Ultra-widefield (UWF) fundus image: 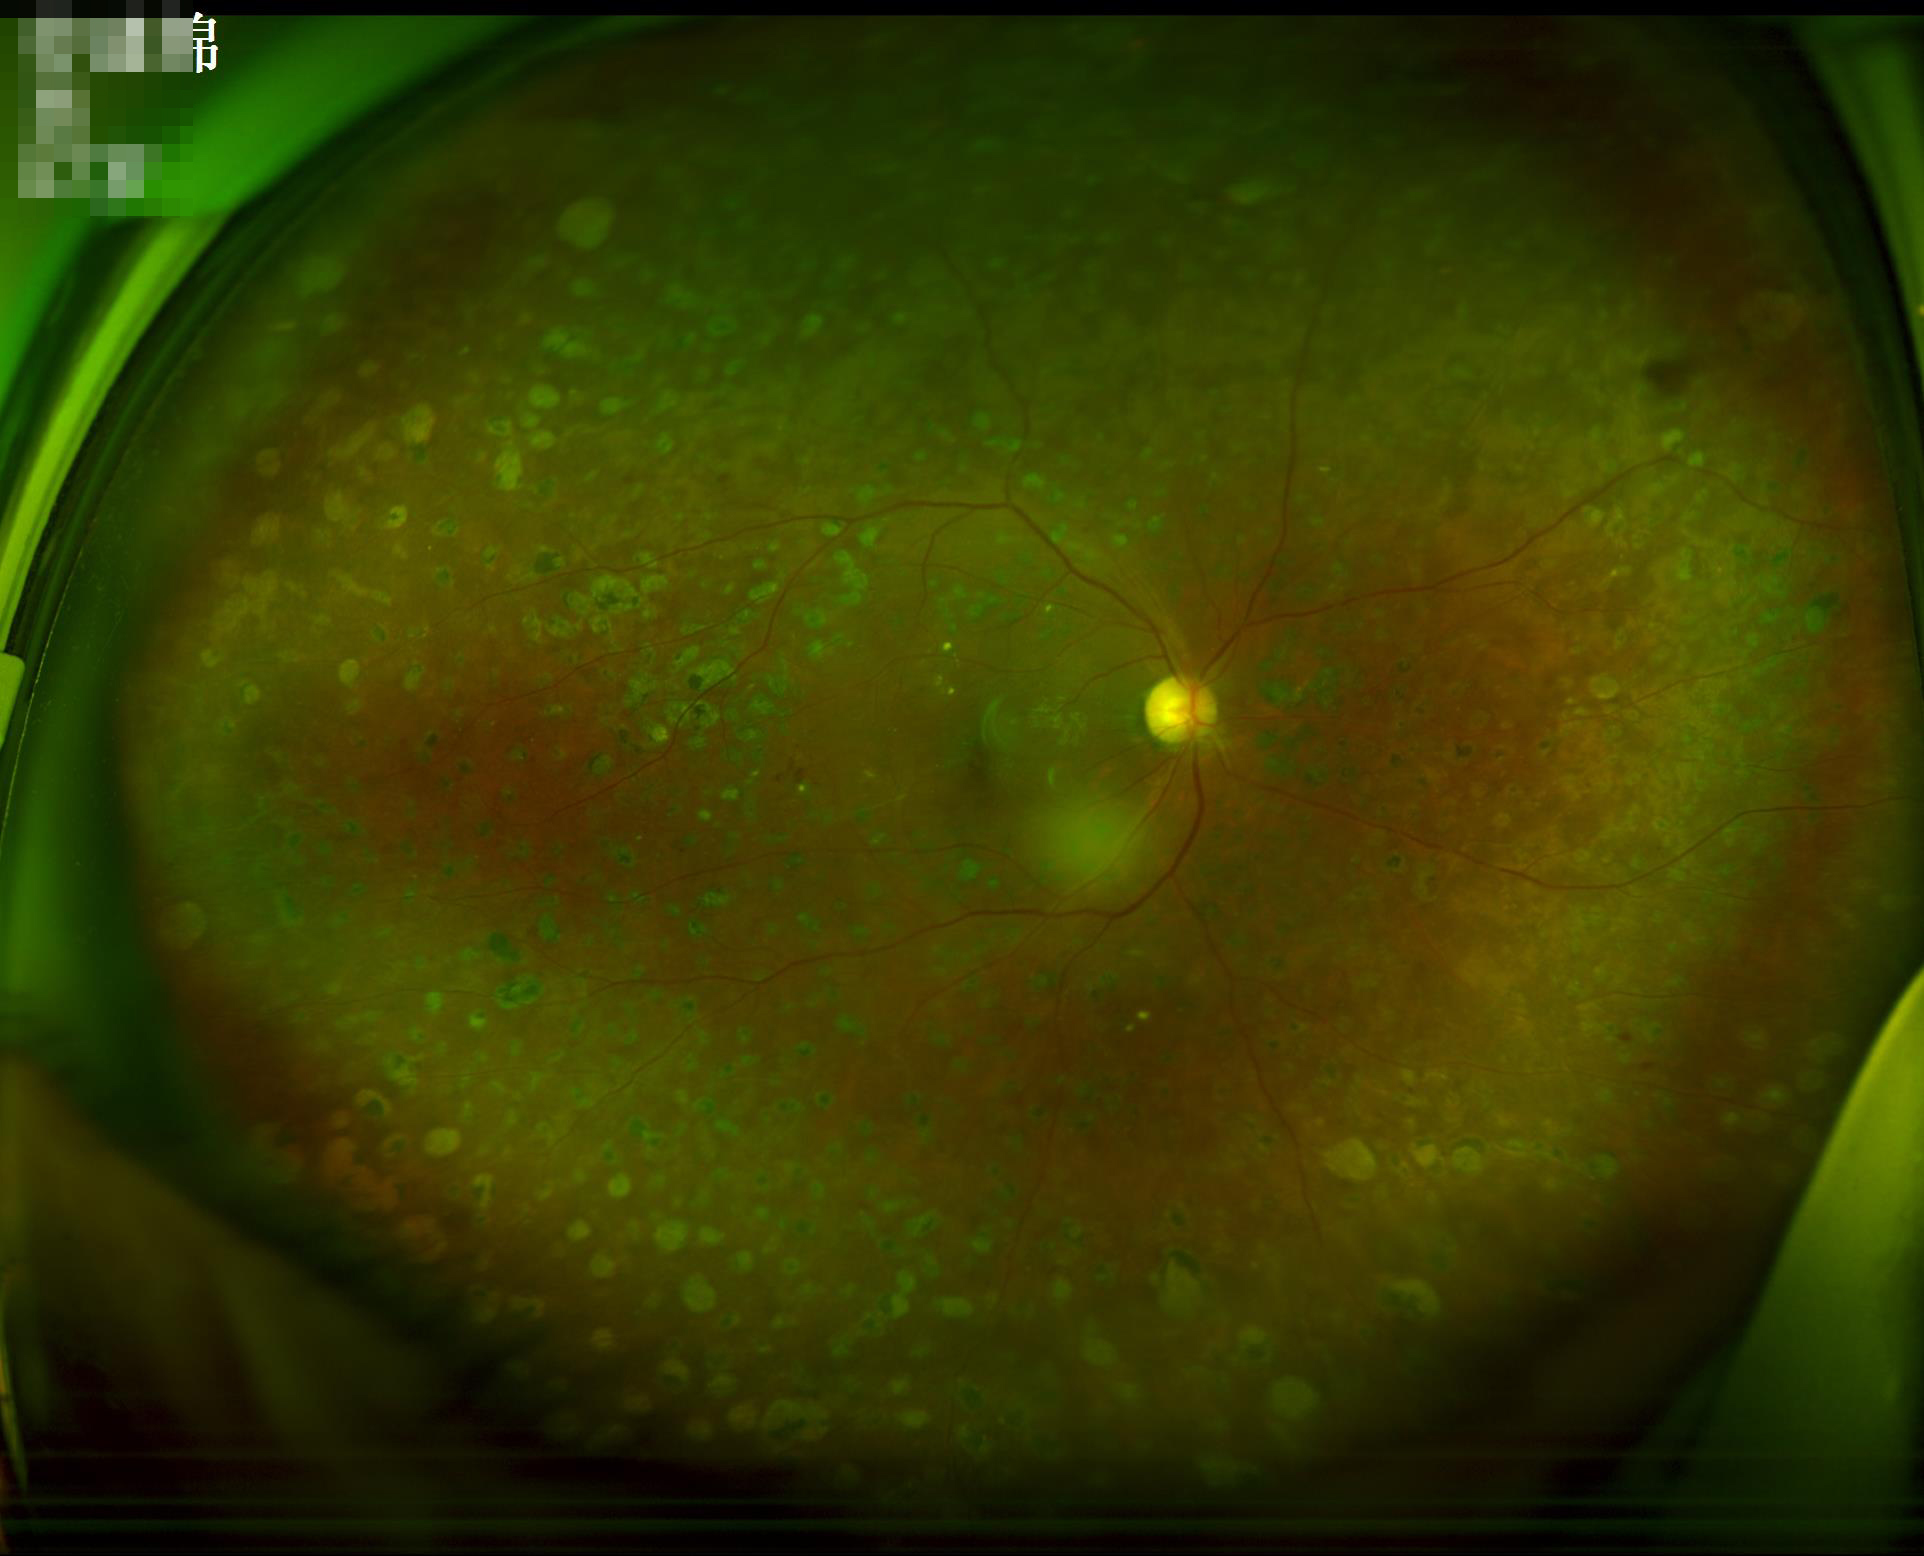
Contrast = good dynamic range; Focus = sharp throughout the field; Illumination/color = good illumination and color balance.